Color fundus image.
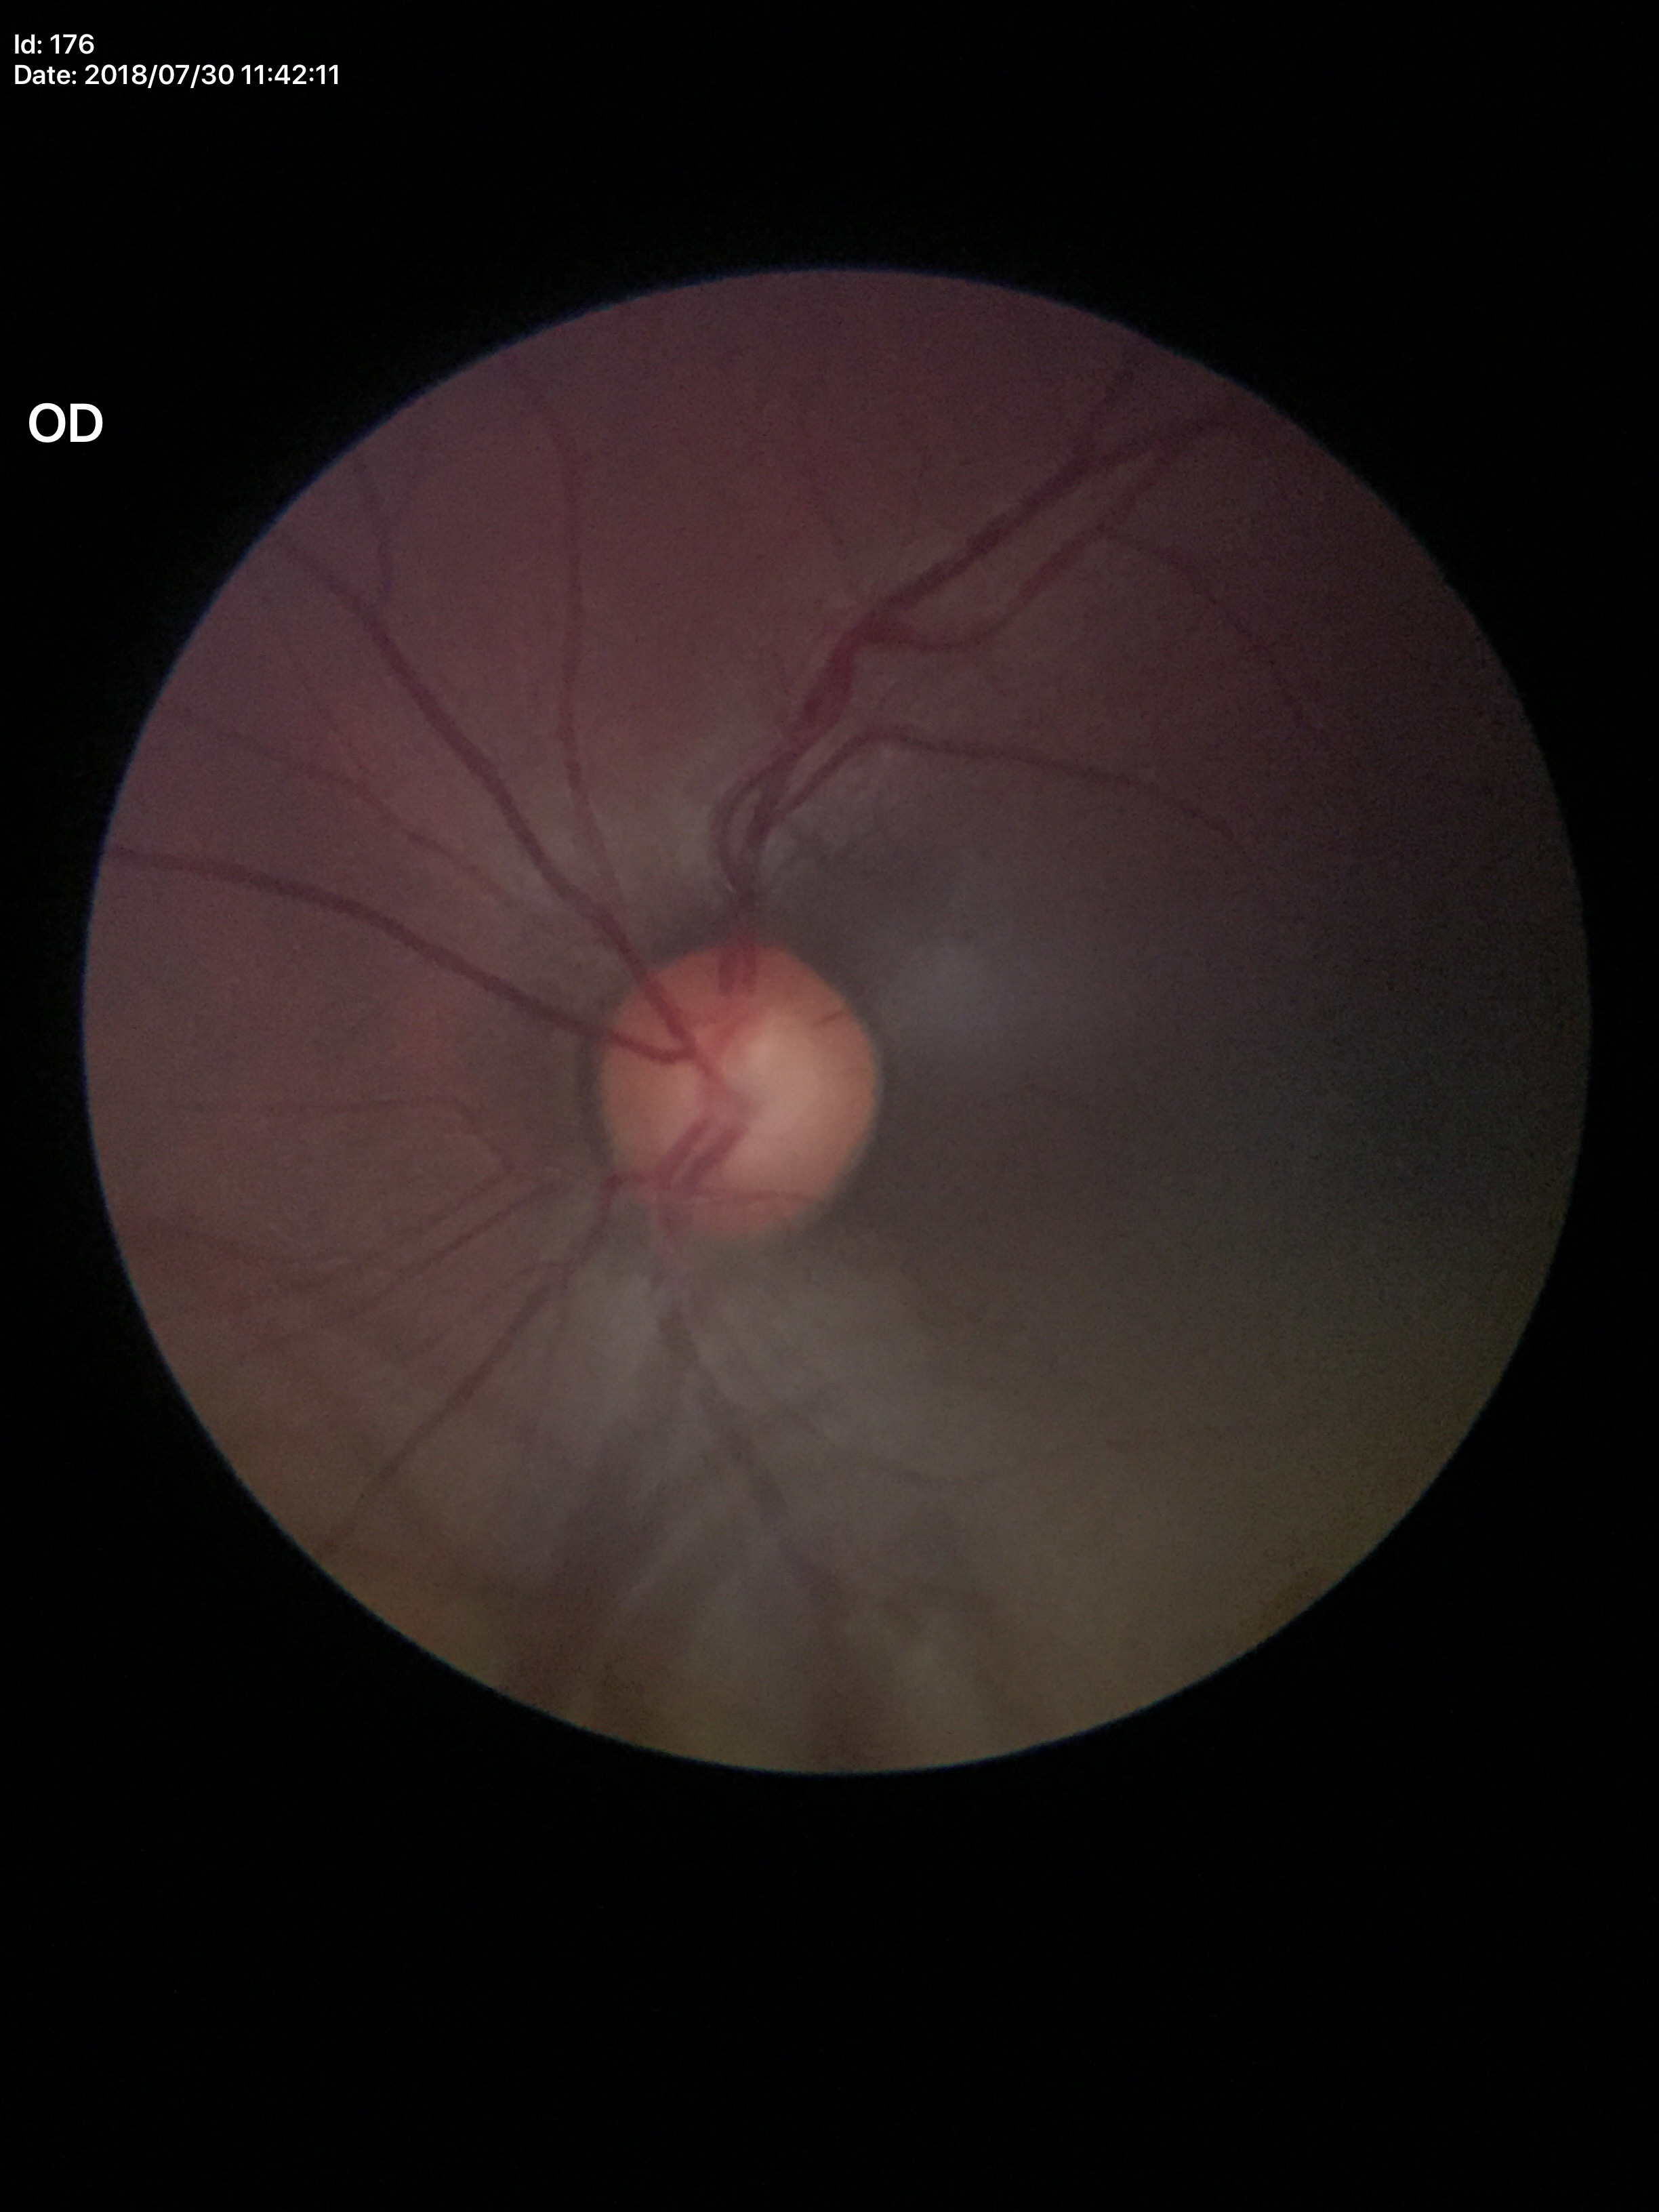
Vertical C/D ratio (VCDR): 0.57.
Glaucoma evaluation: not suspect.